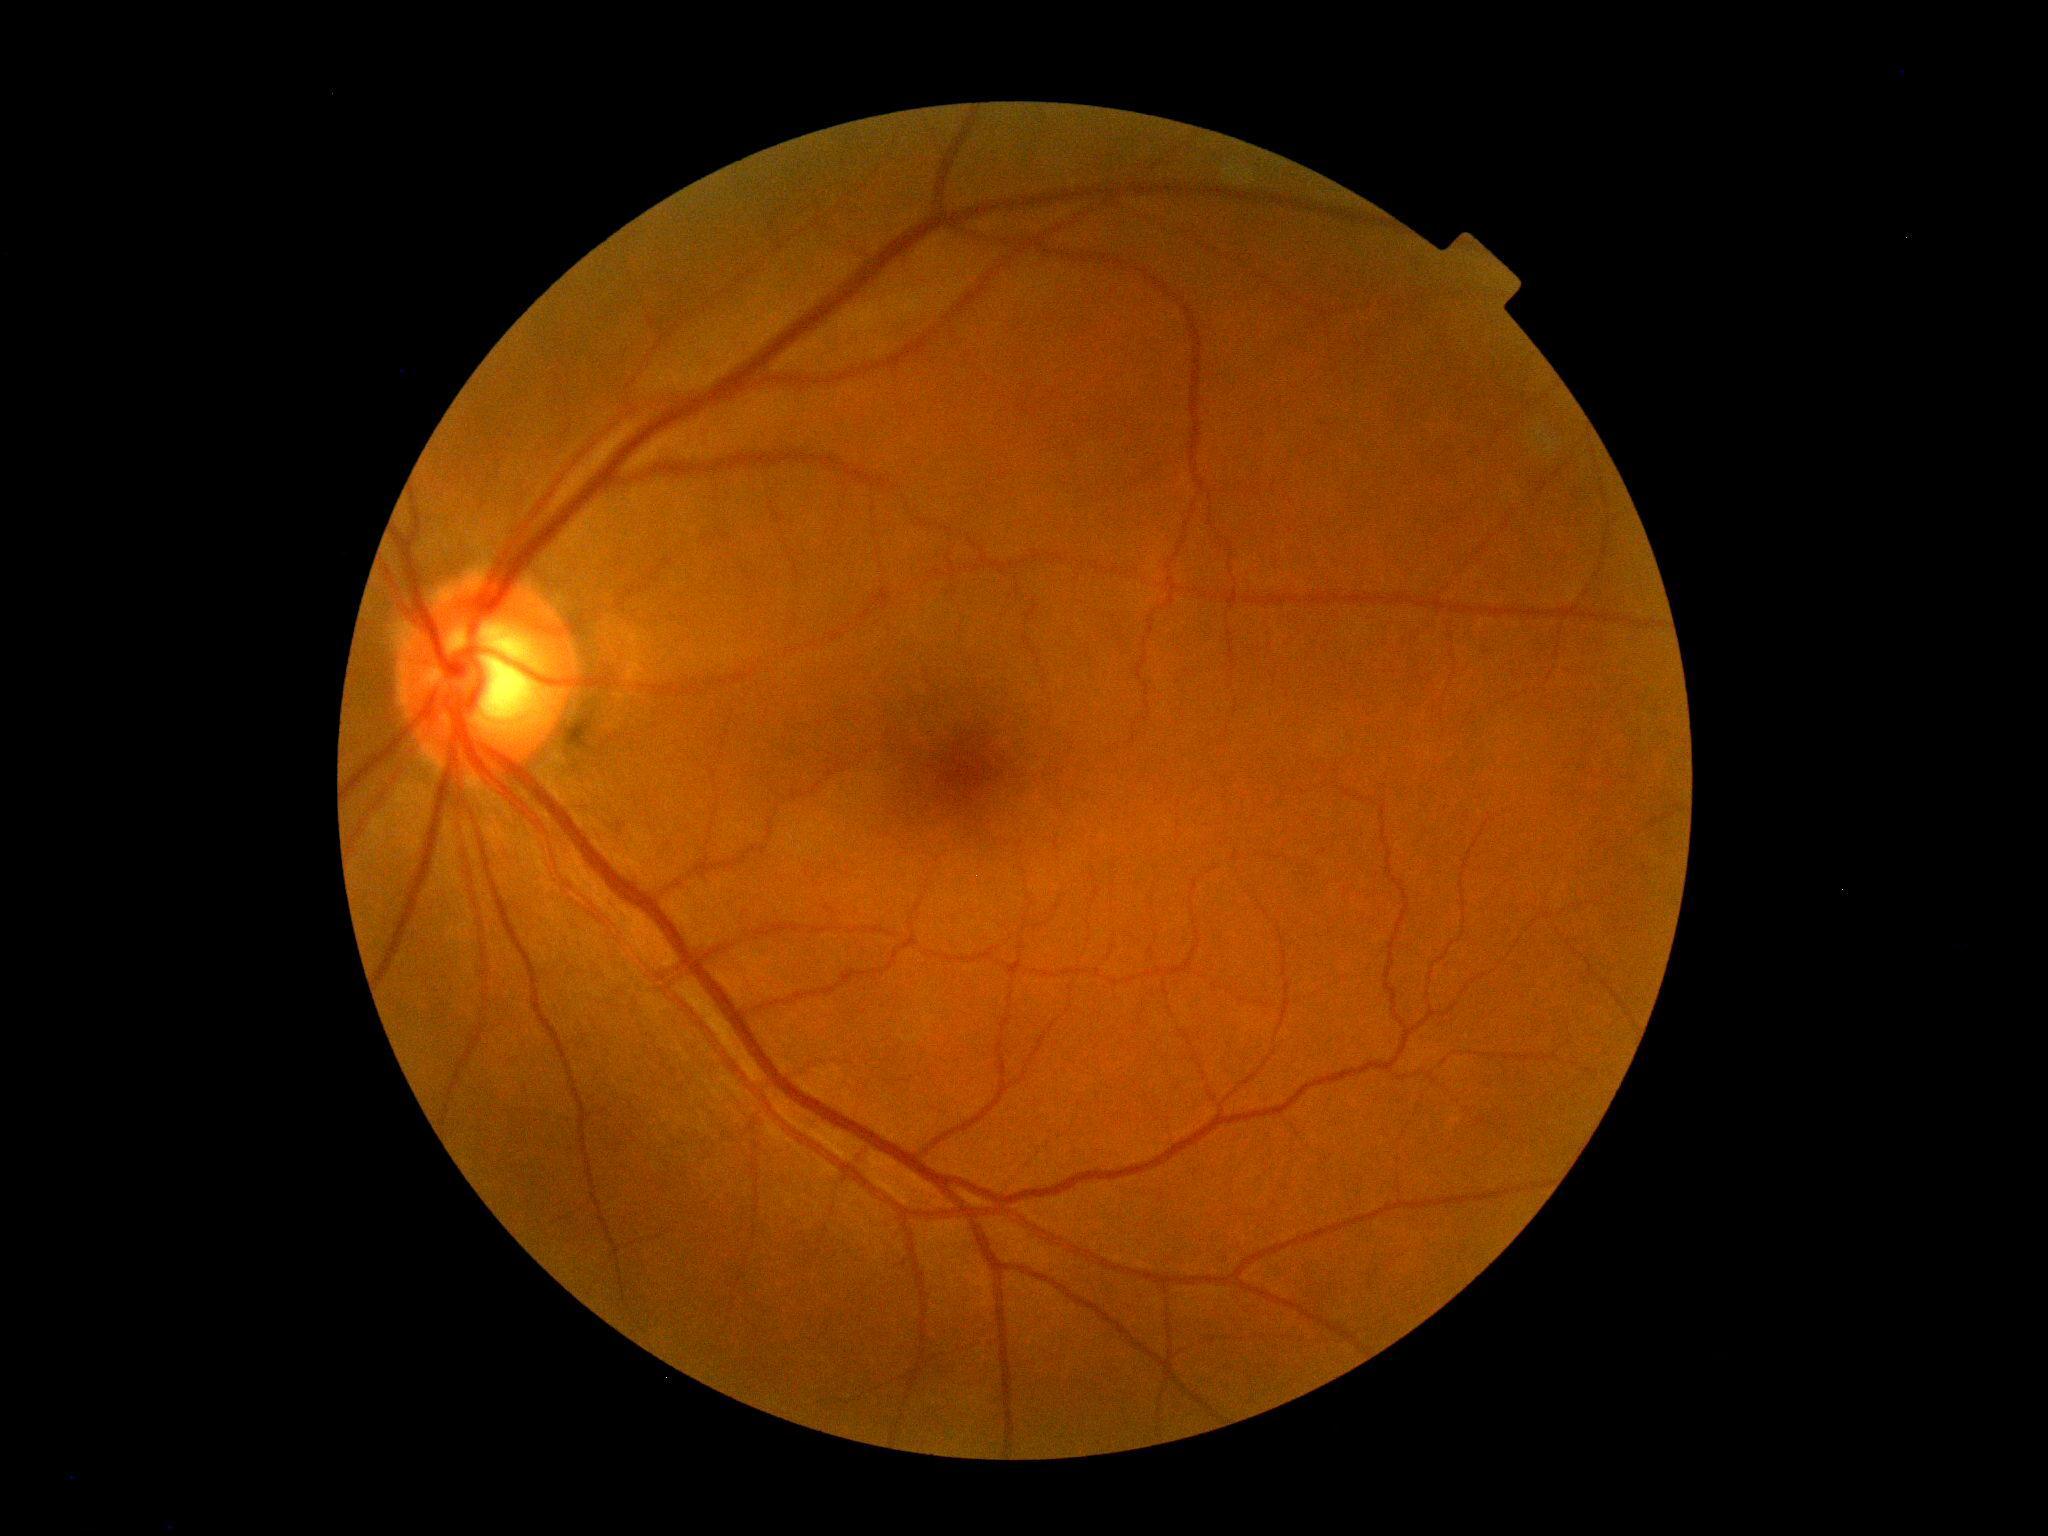 retinopathy grade: 0; DR impression: no signs of DR.